Color fundus image
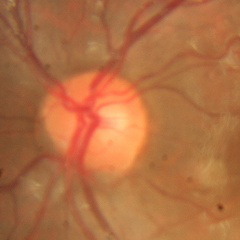 Findings consistent with no glaucoma.